CFP — 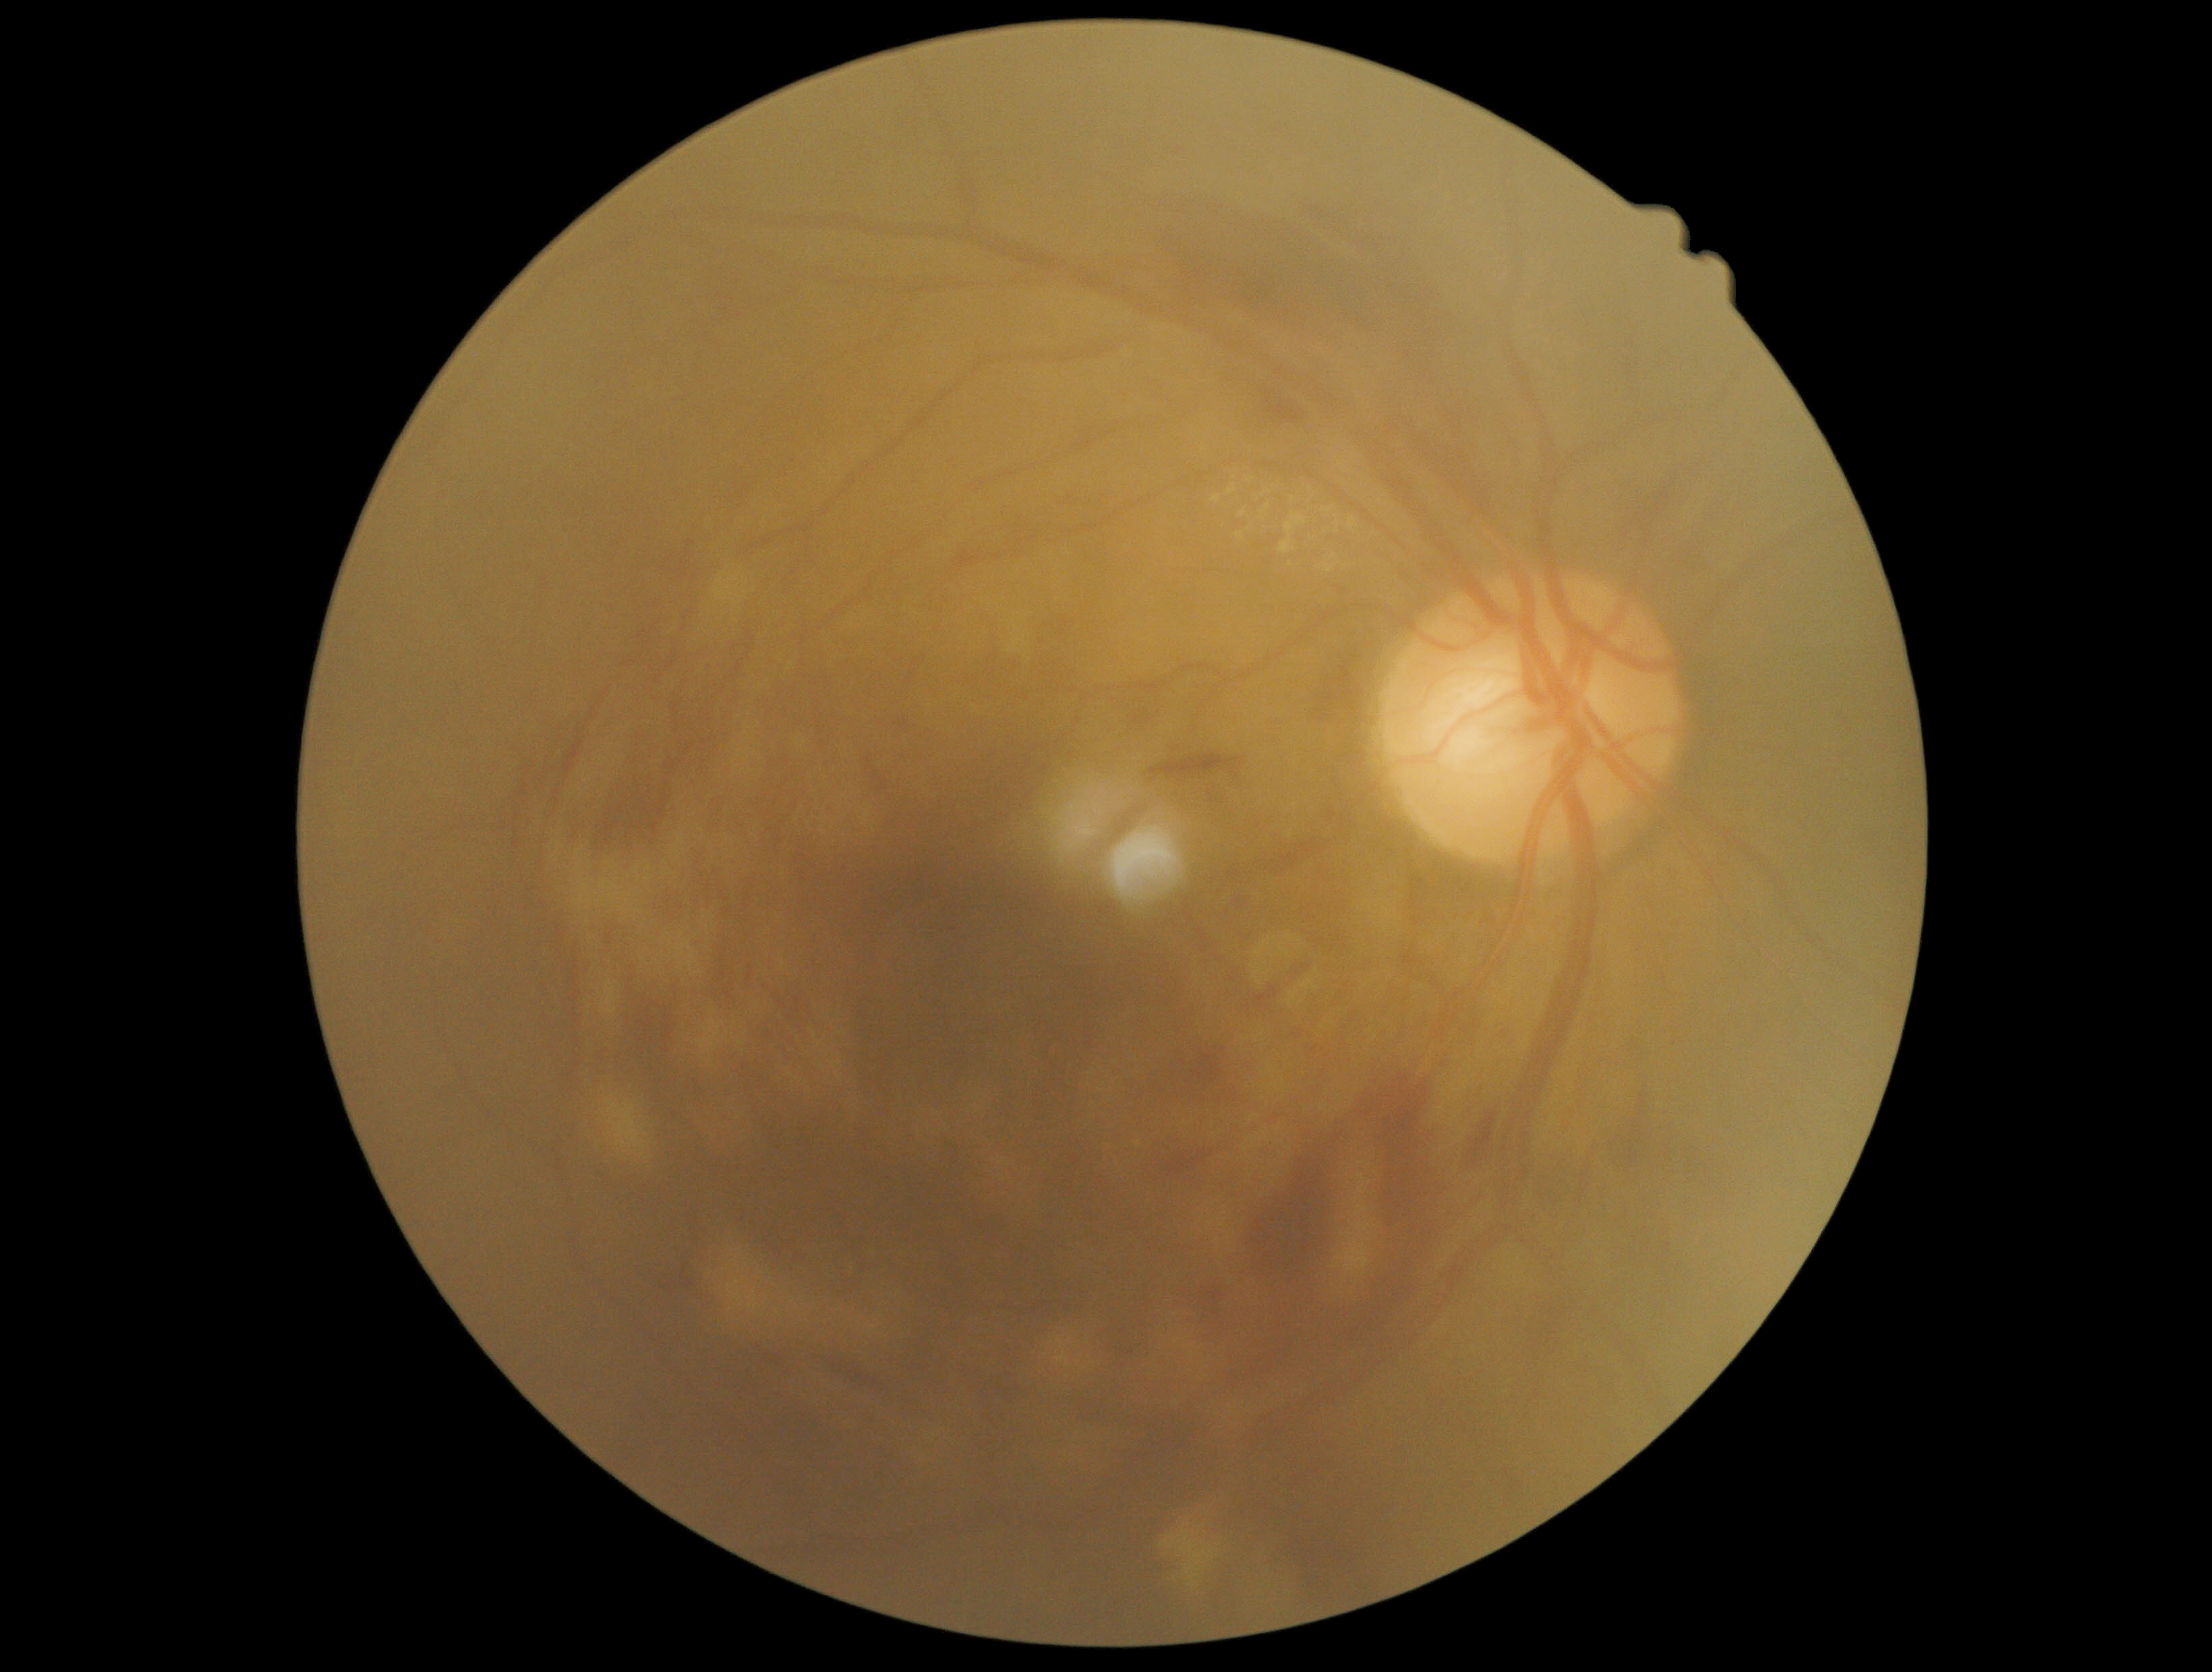 DR class: non-proliferative diabetic retinopathy, DR severity: grade 2 (moderate NPDR).